2048x1536 — 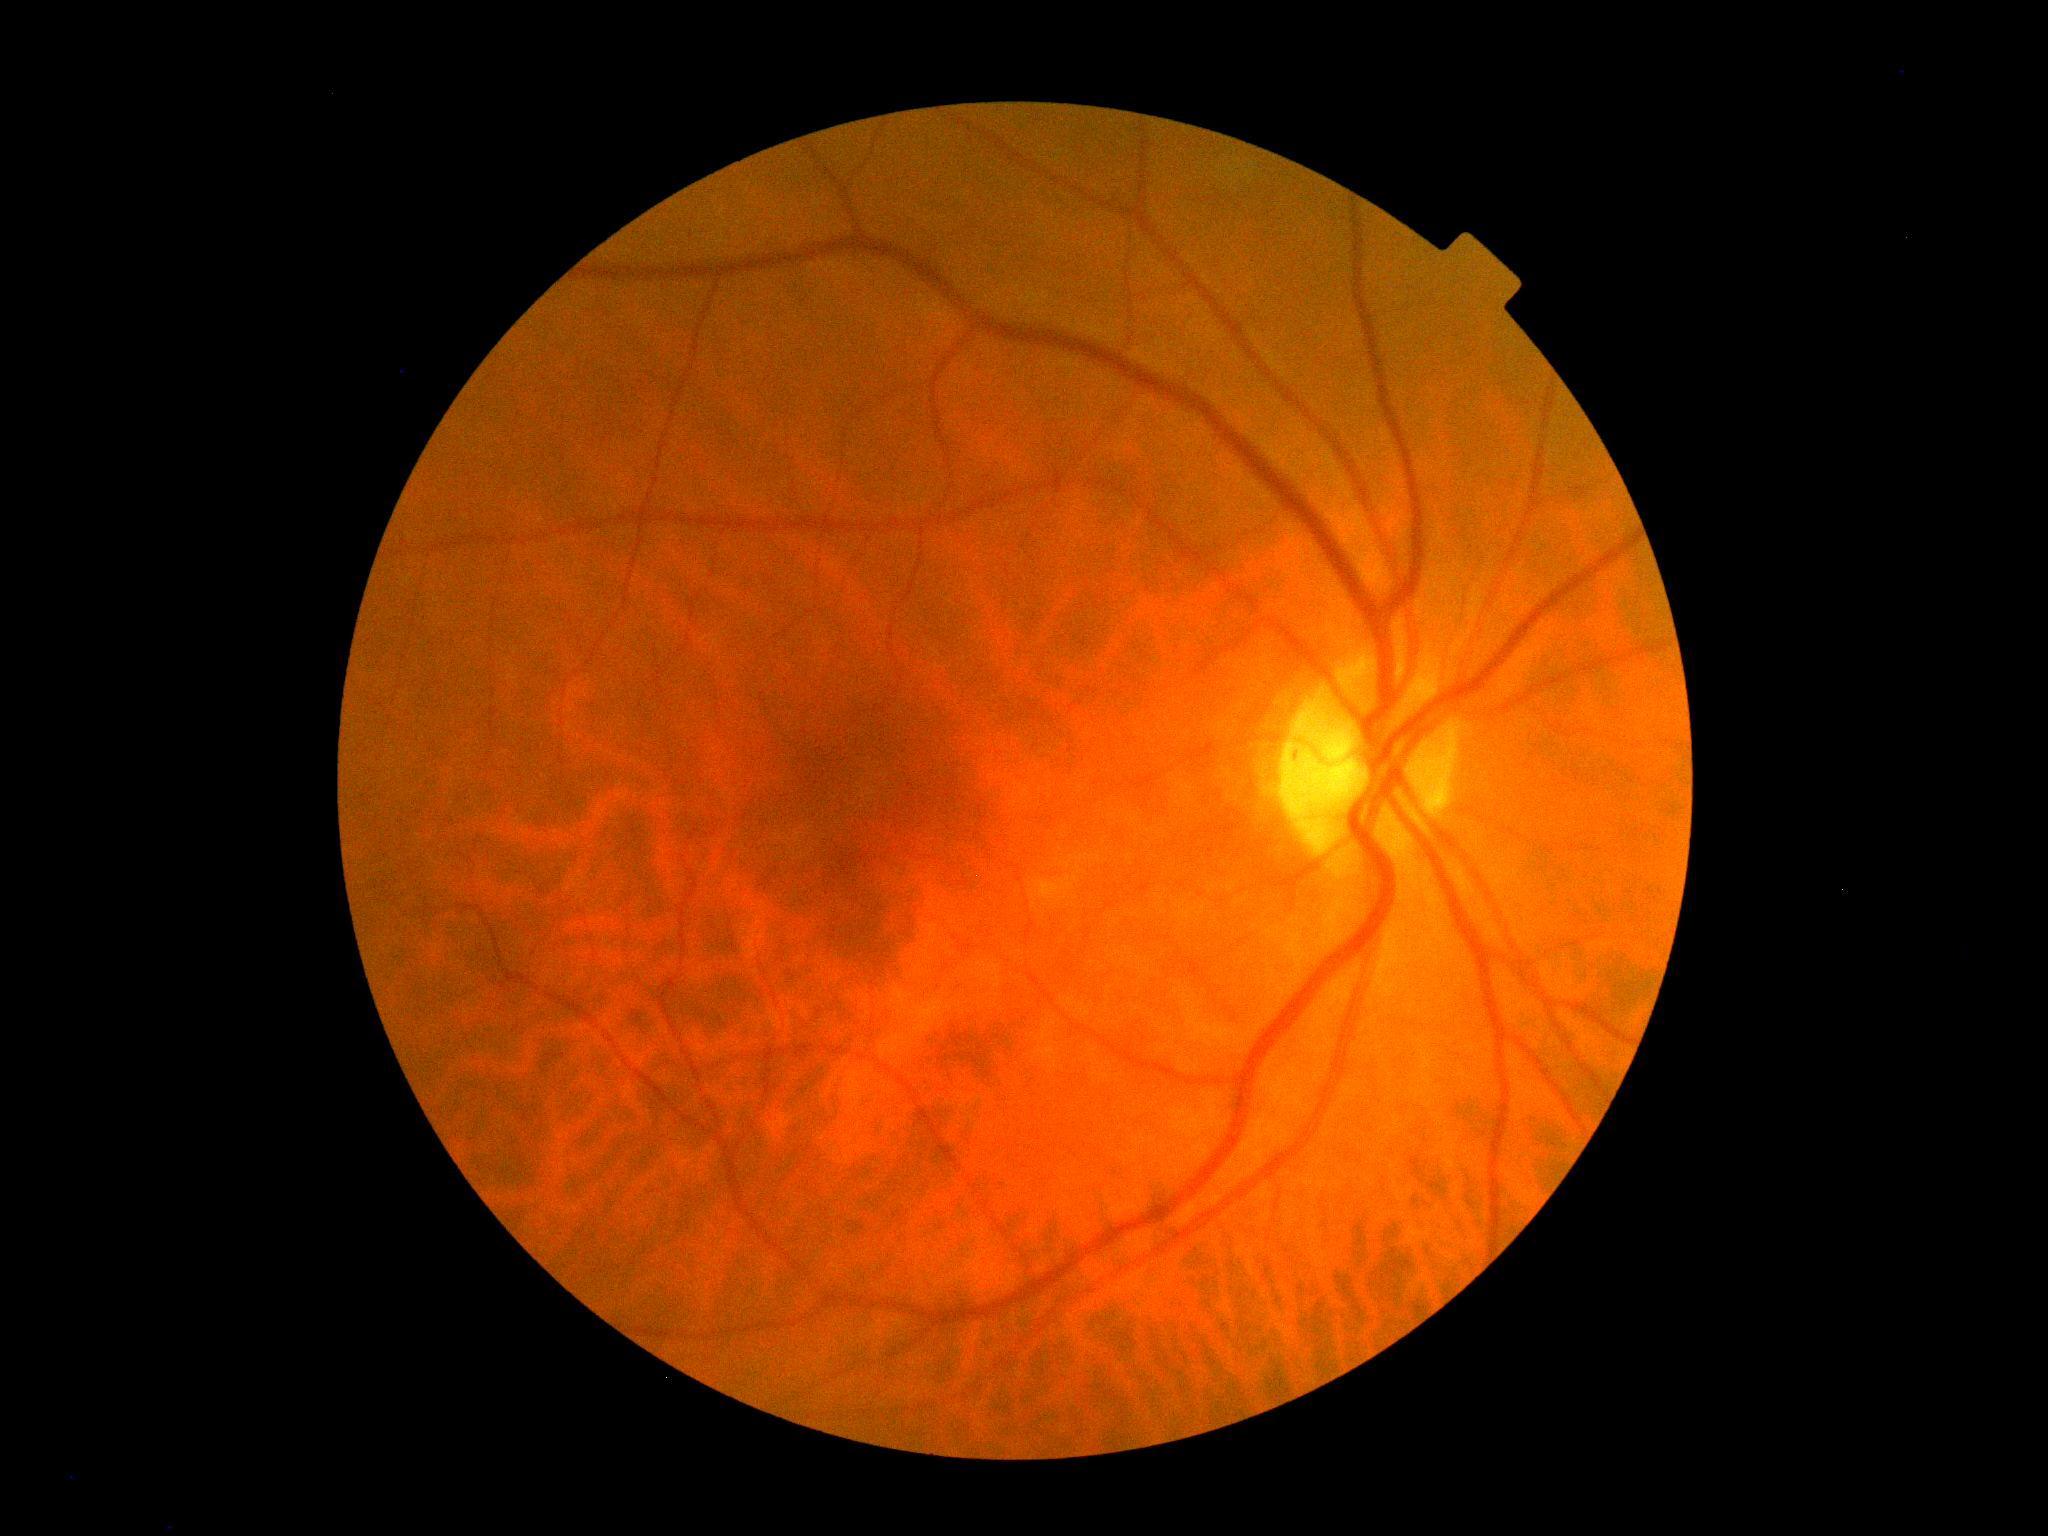

DR stage is 0/4.